1240 by 1240 pixels; infant wide-field fundus photograph.
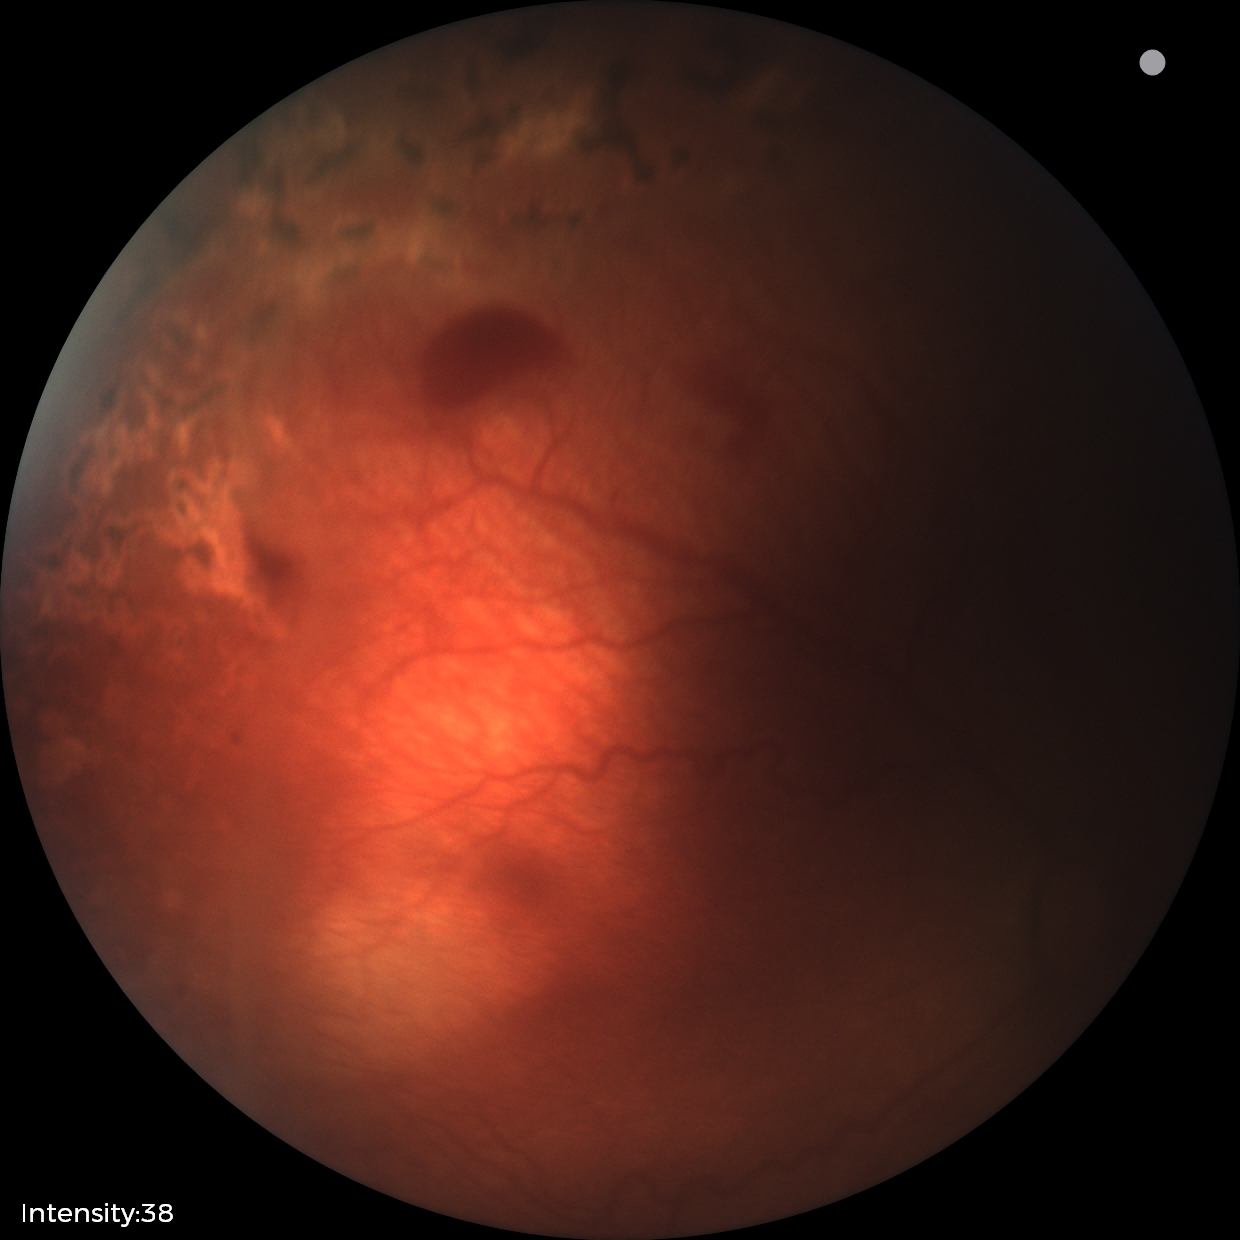

Screening: no plus disease; status post ROP.